Davis DR grading:
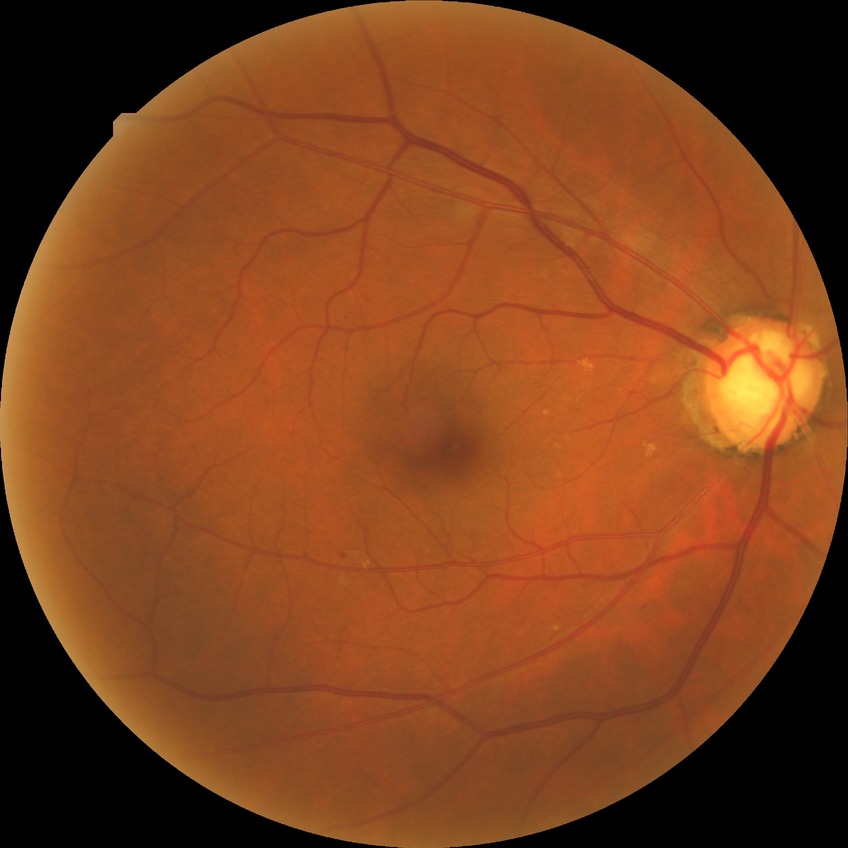
Diabetic retinopathy (DR) is NDR (no diabetic retinopathy).